1725 by 1721 pixels. 45° FOV. Retinal fundus photograph
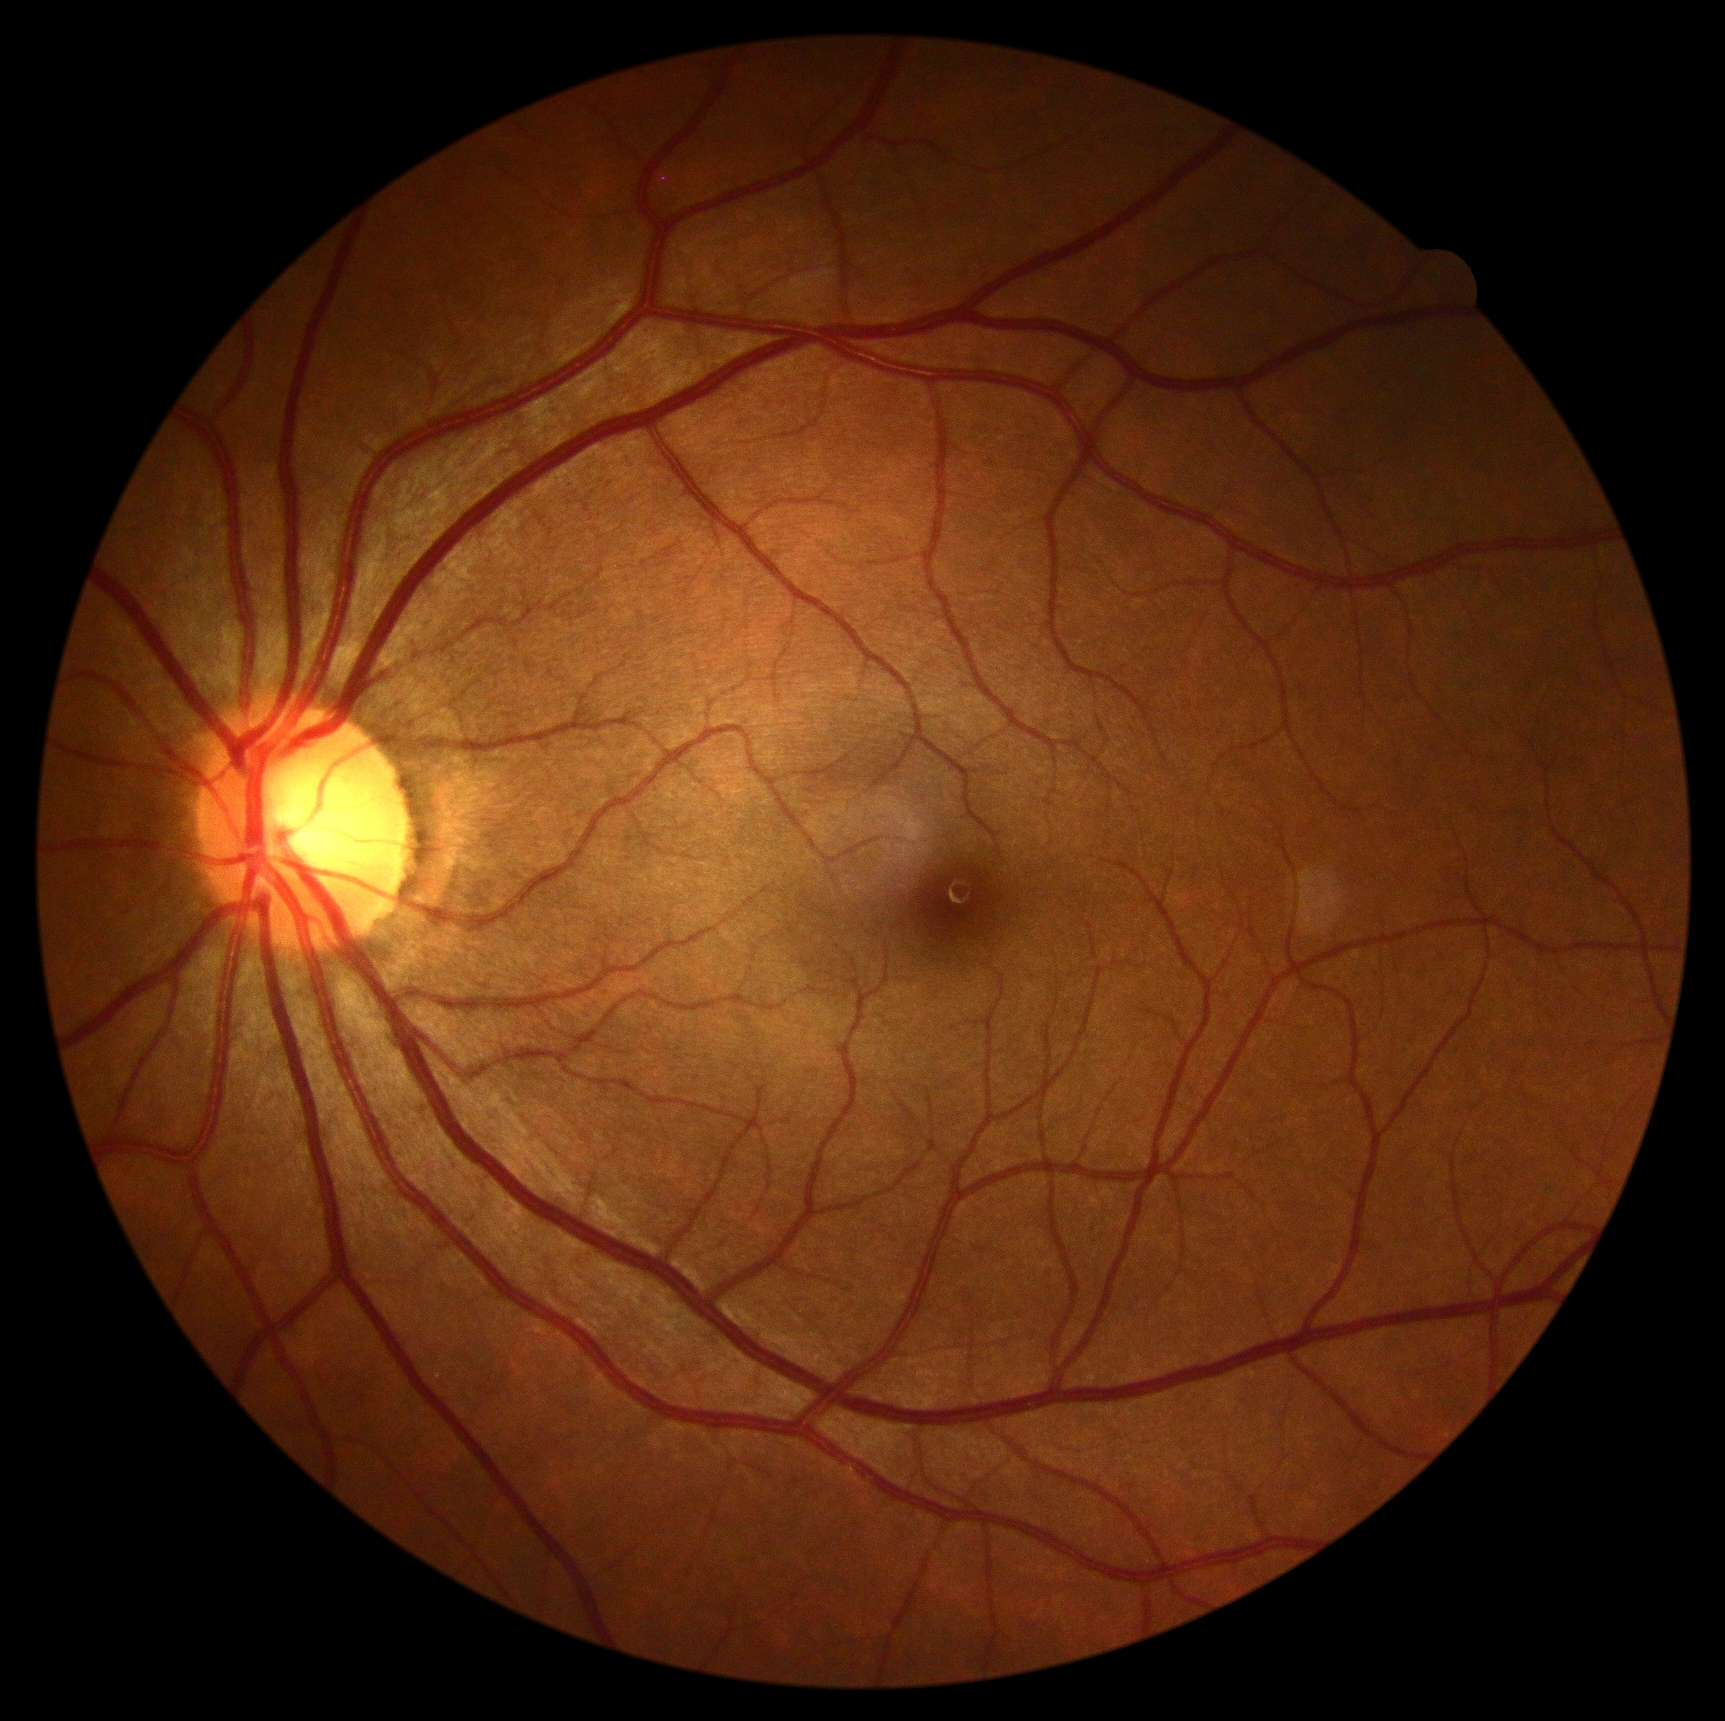

Diabetic retinopathy is grade 0 — no visible signs of diabetic retinopathy.